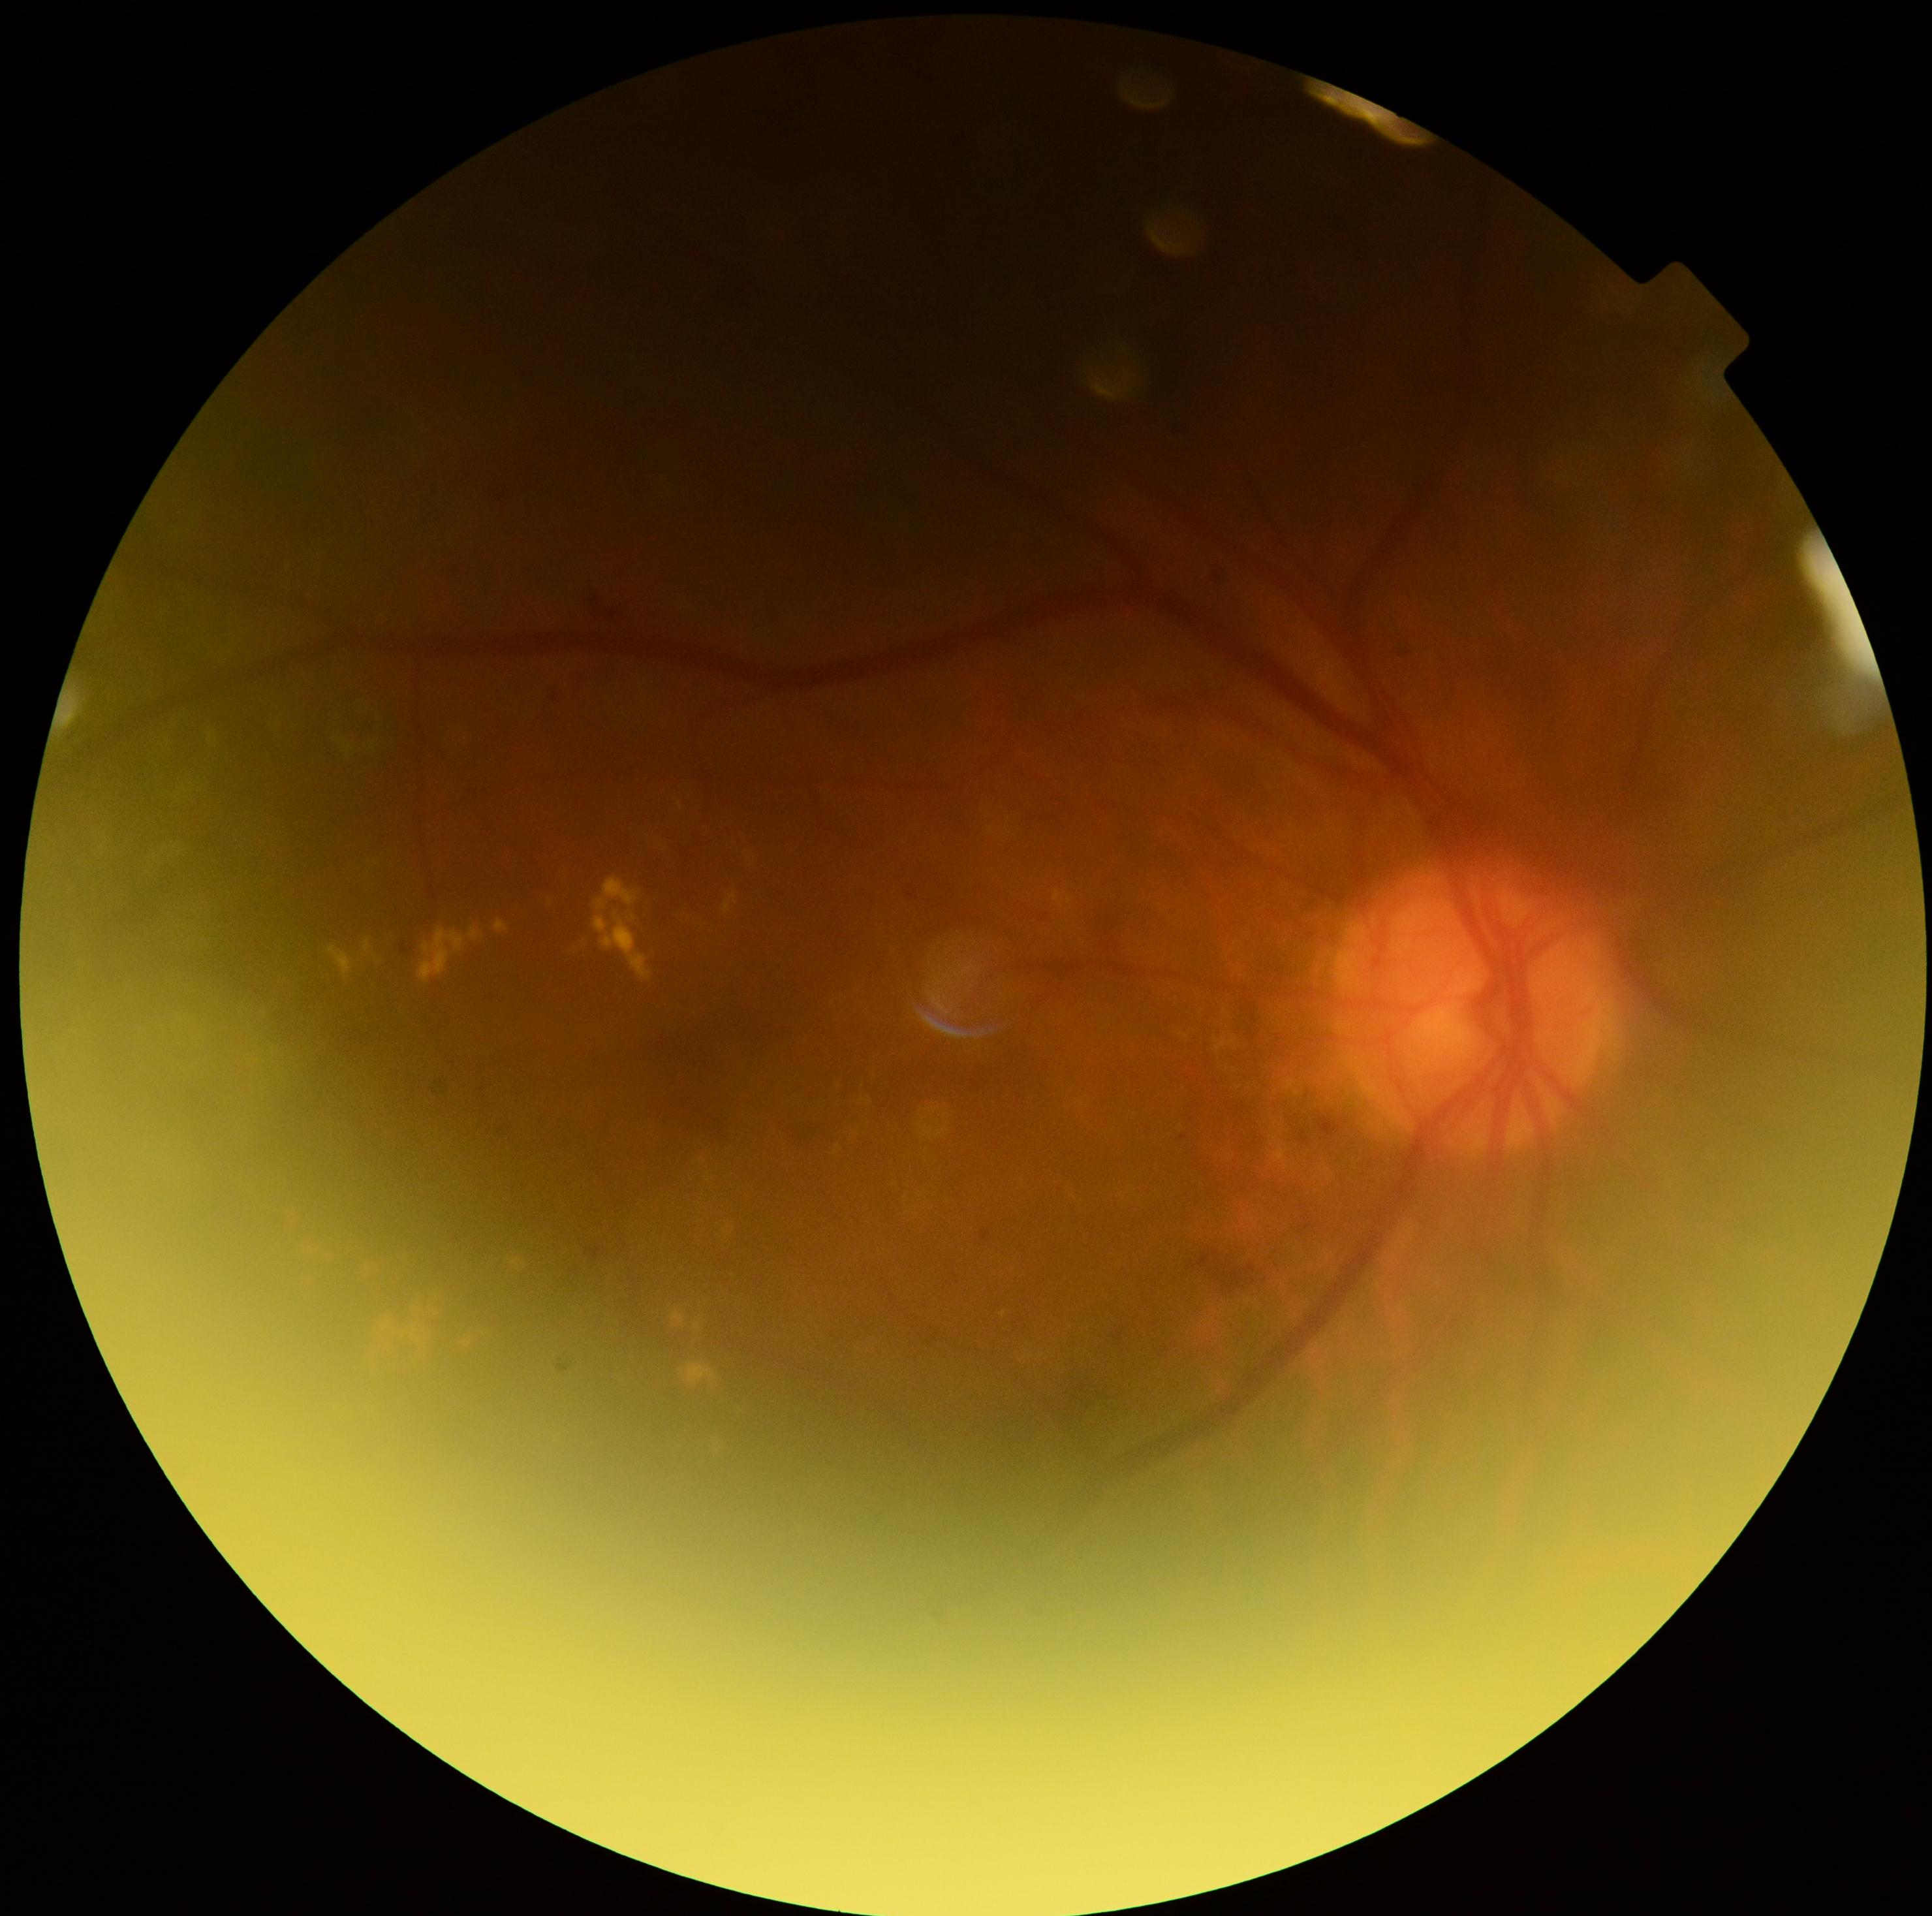
DR grade: moderate non-proliferative diabetic retinopathy (2).